Image size 848x848; 45° FOV; camera: NIDEK AFC-230; nonmydriatic: 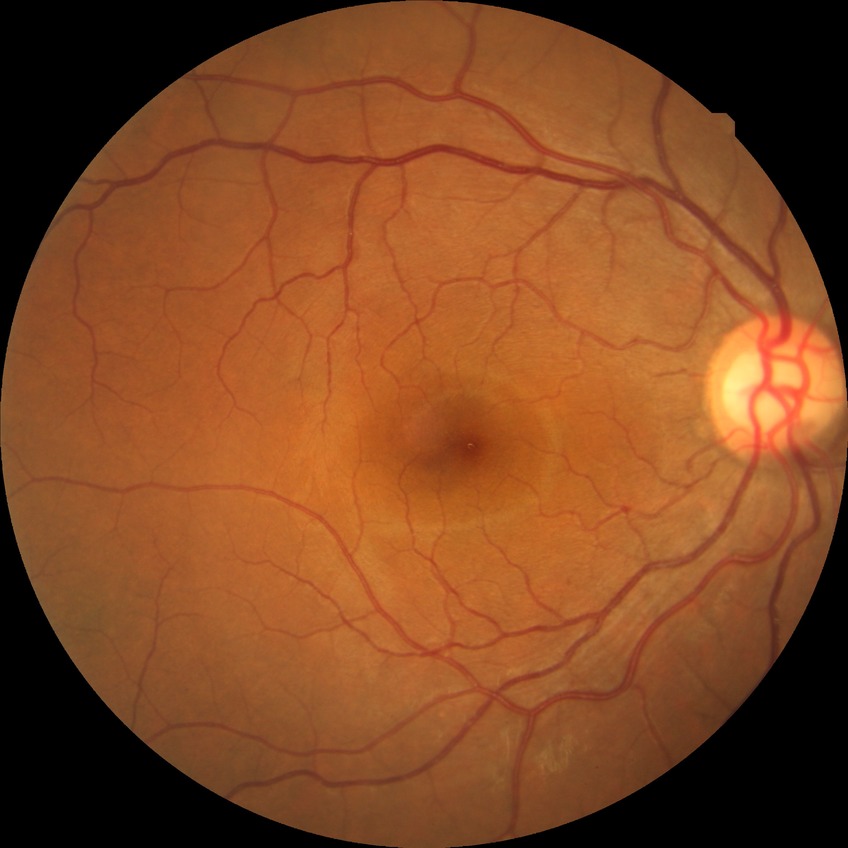
diabetic retinopathy (DR): no diabetic retinopathy (NDR).